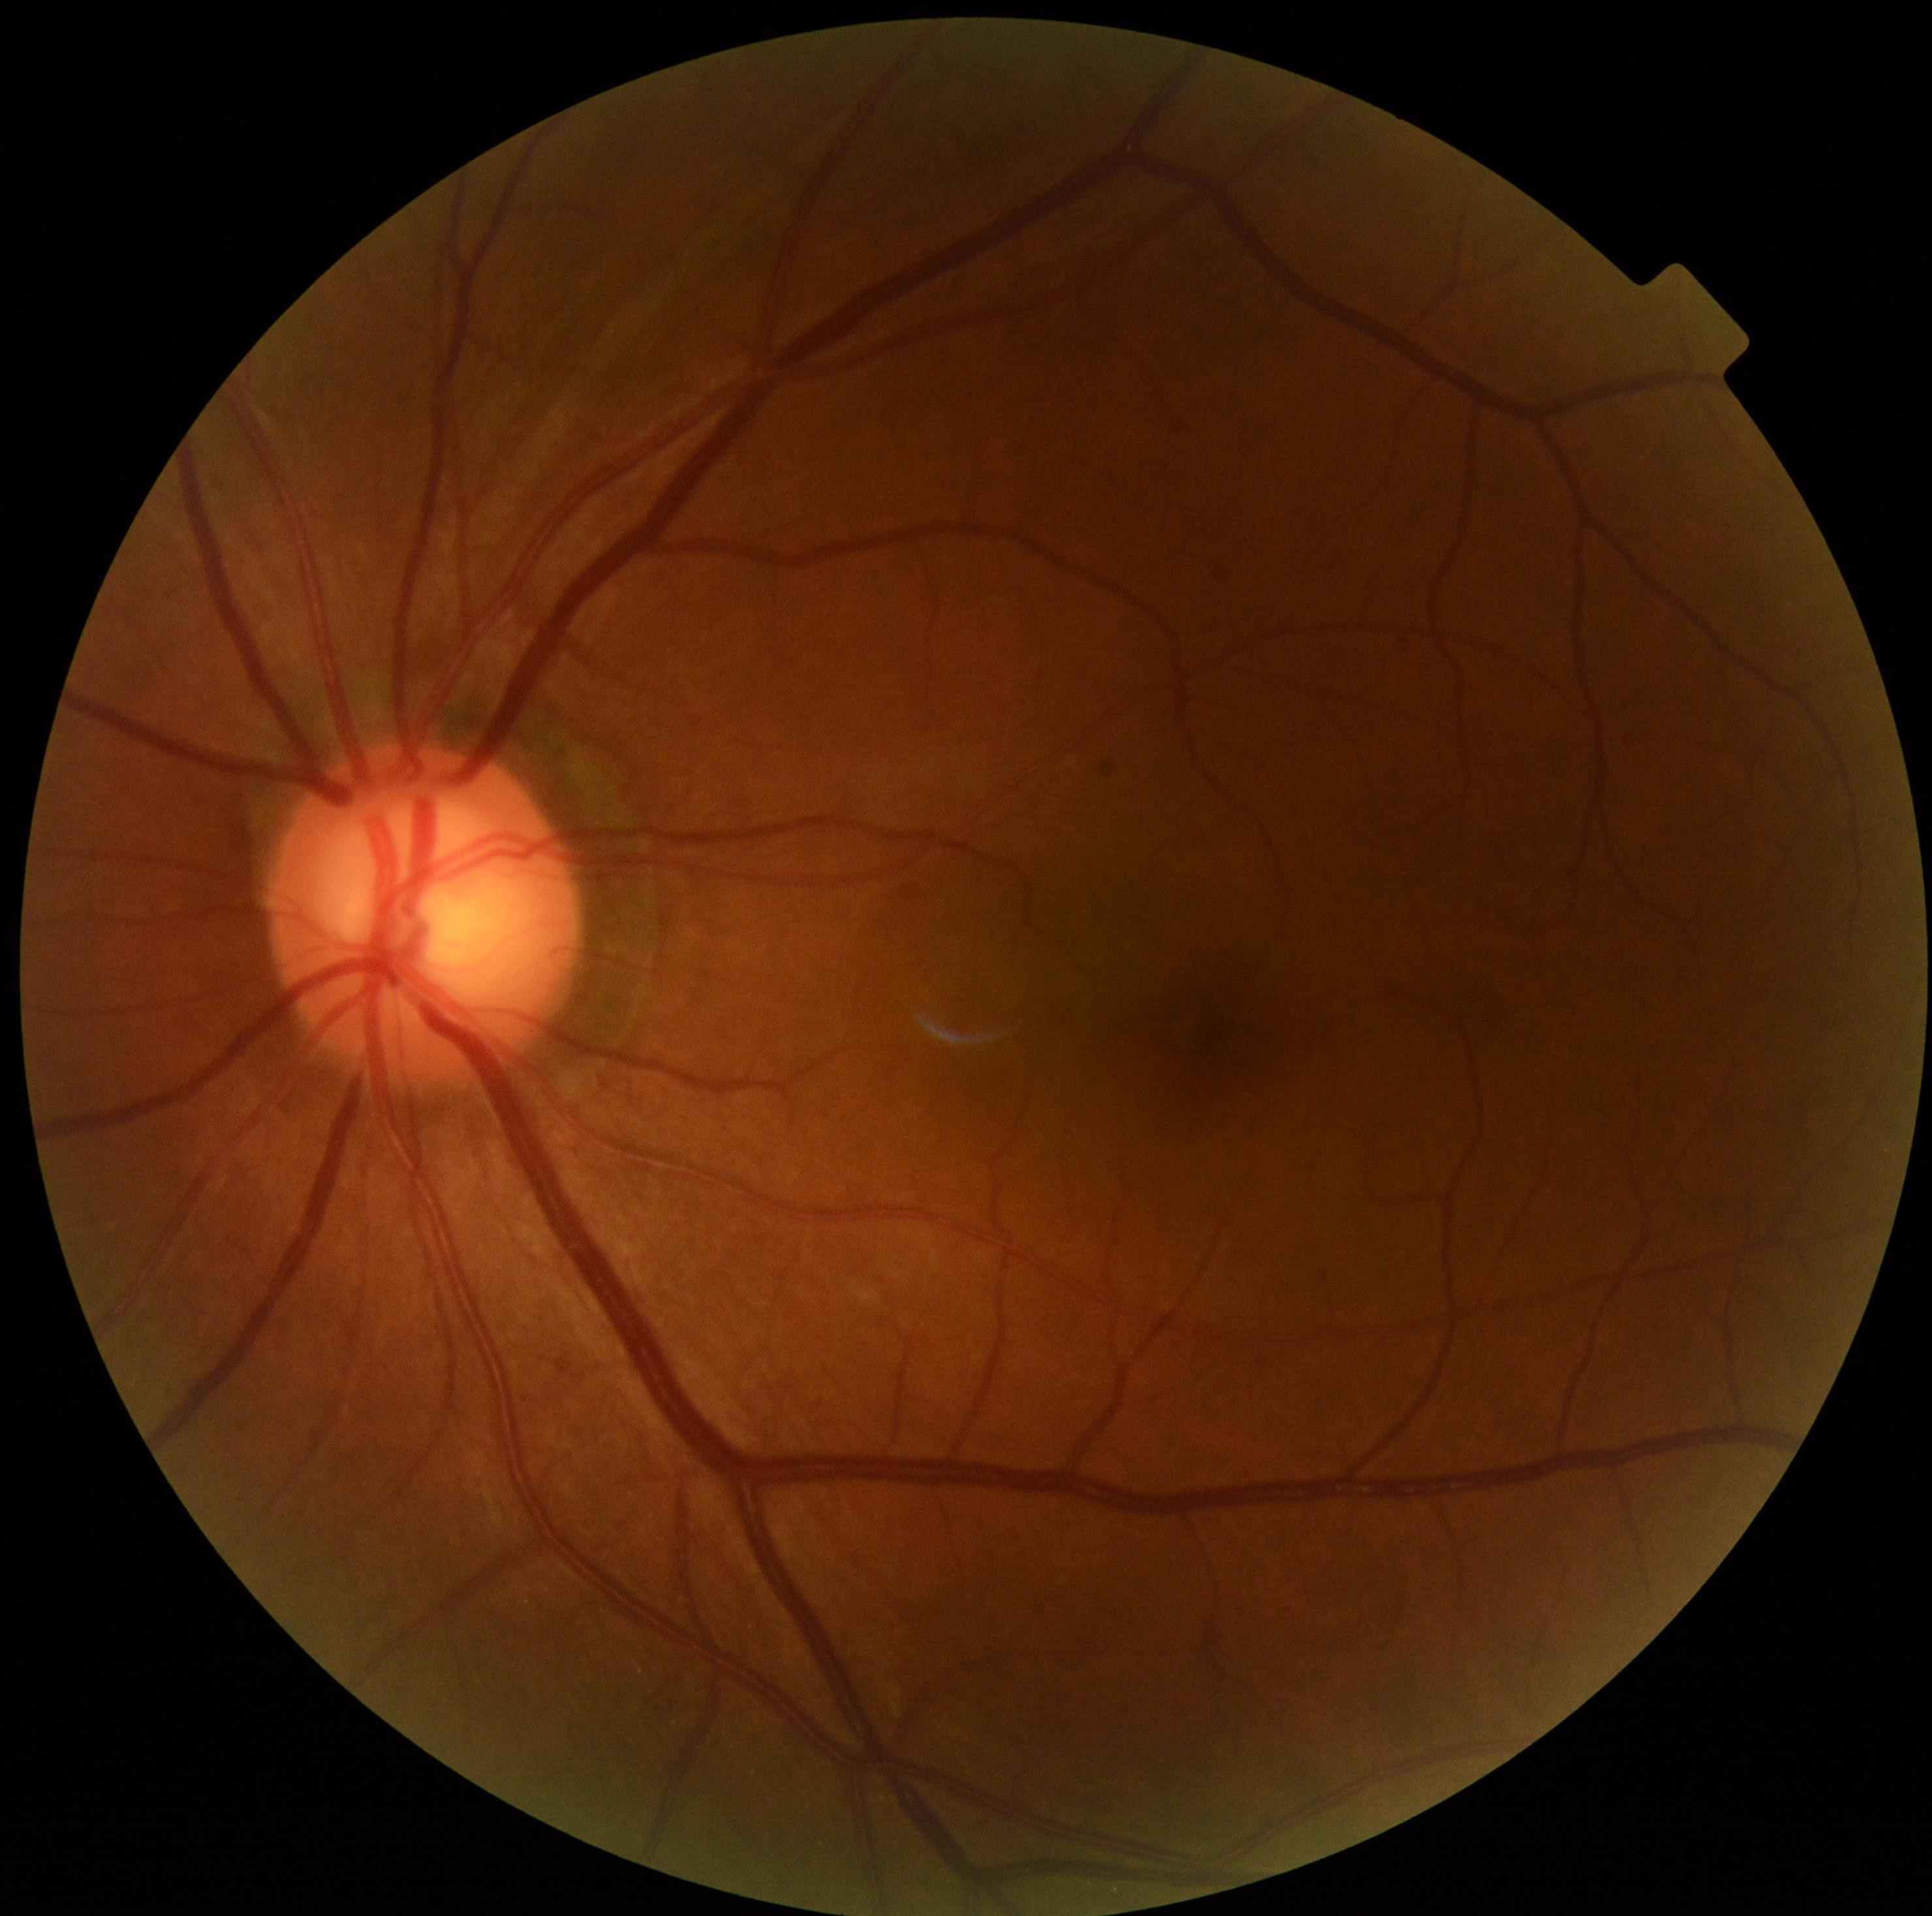
Retinopathy is 0/4. No diabetic retinal disease findings.